2212x1659px:
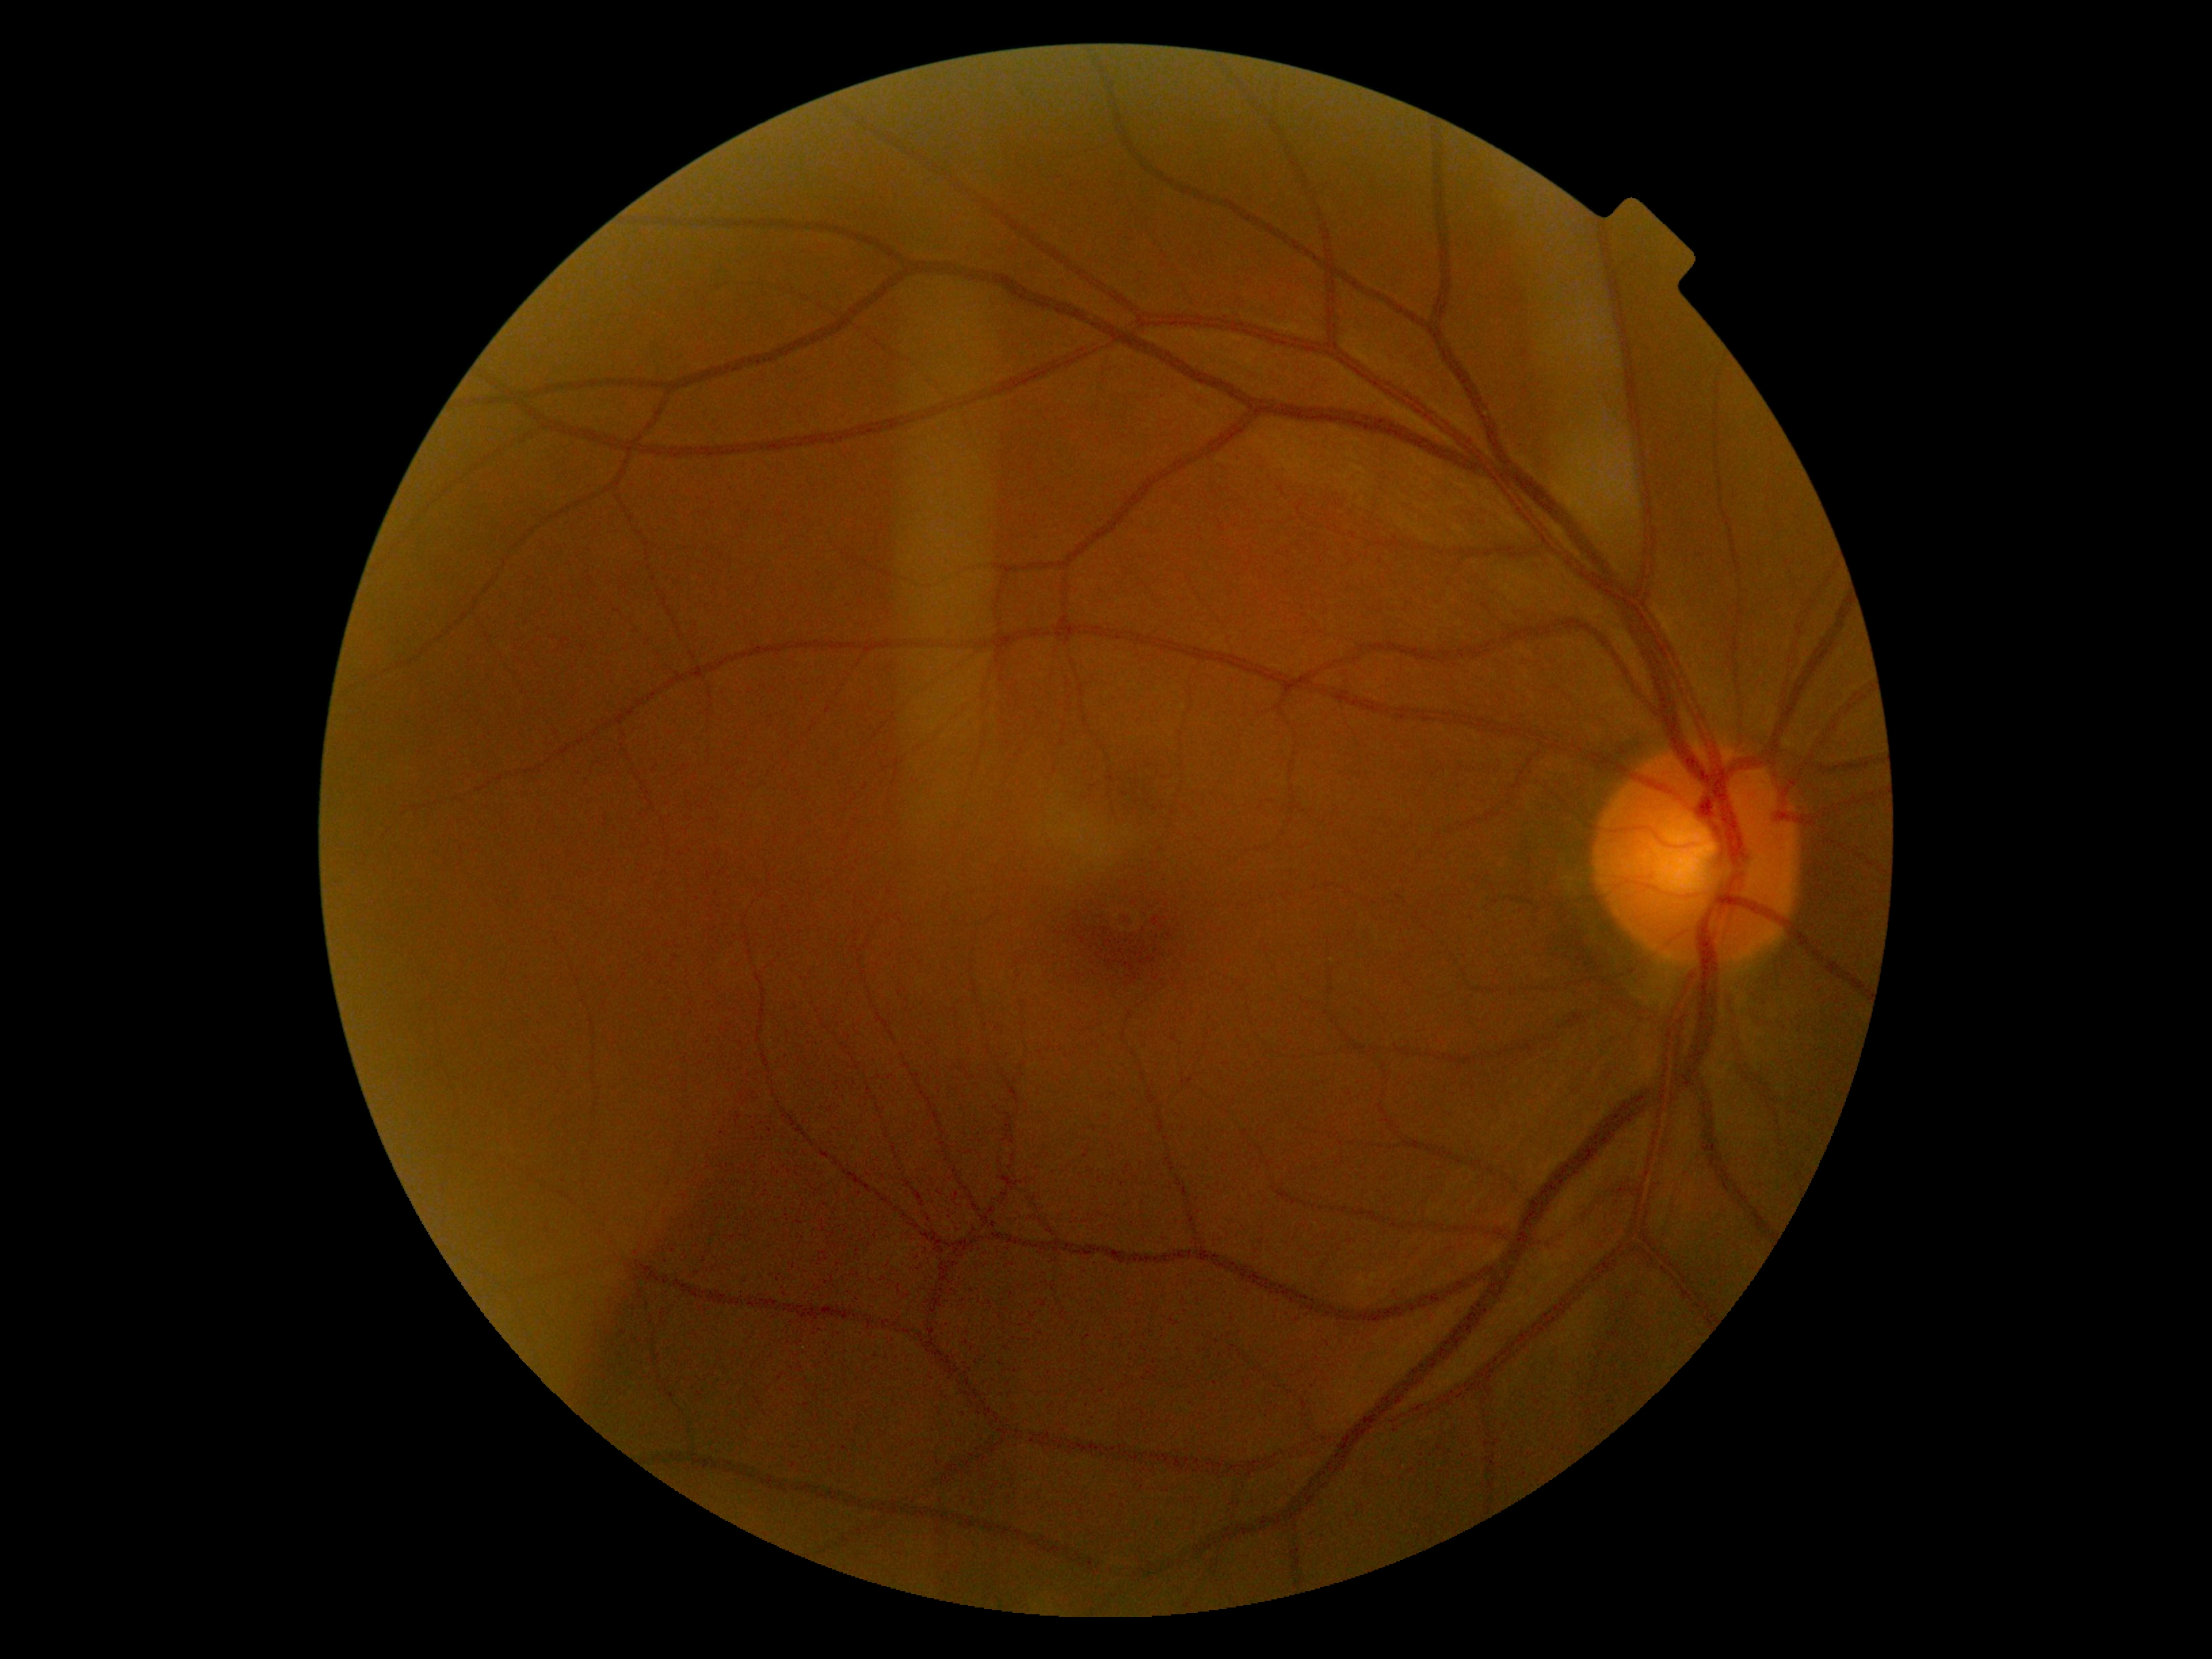

{"dr_grade": "grade 0 (no apparent retinopathy)", "dr_impression": "no DR findings"}